45° FOV; retinal fundus photograph: 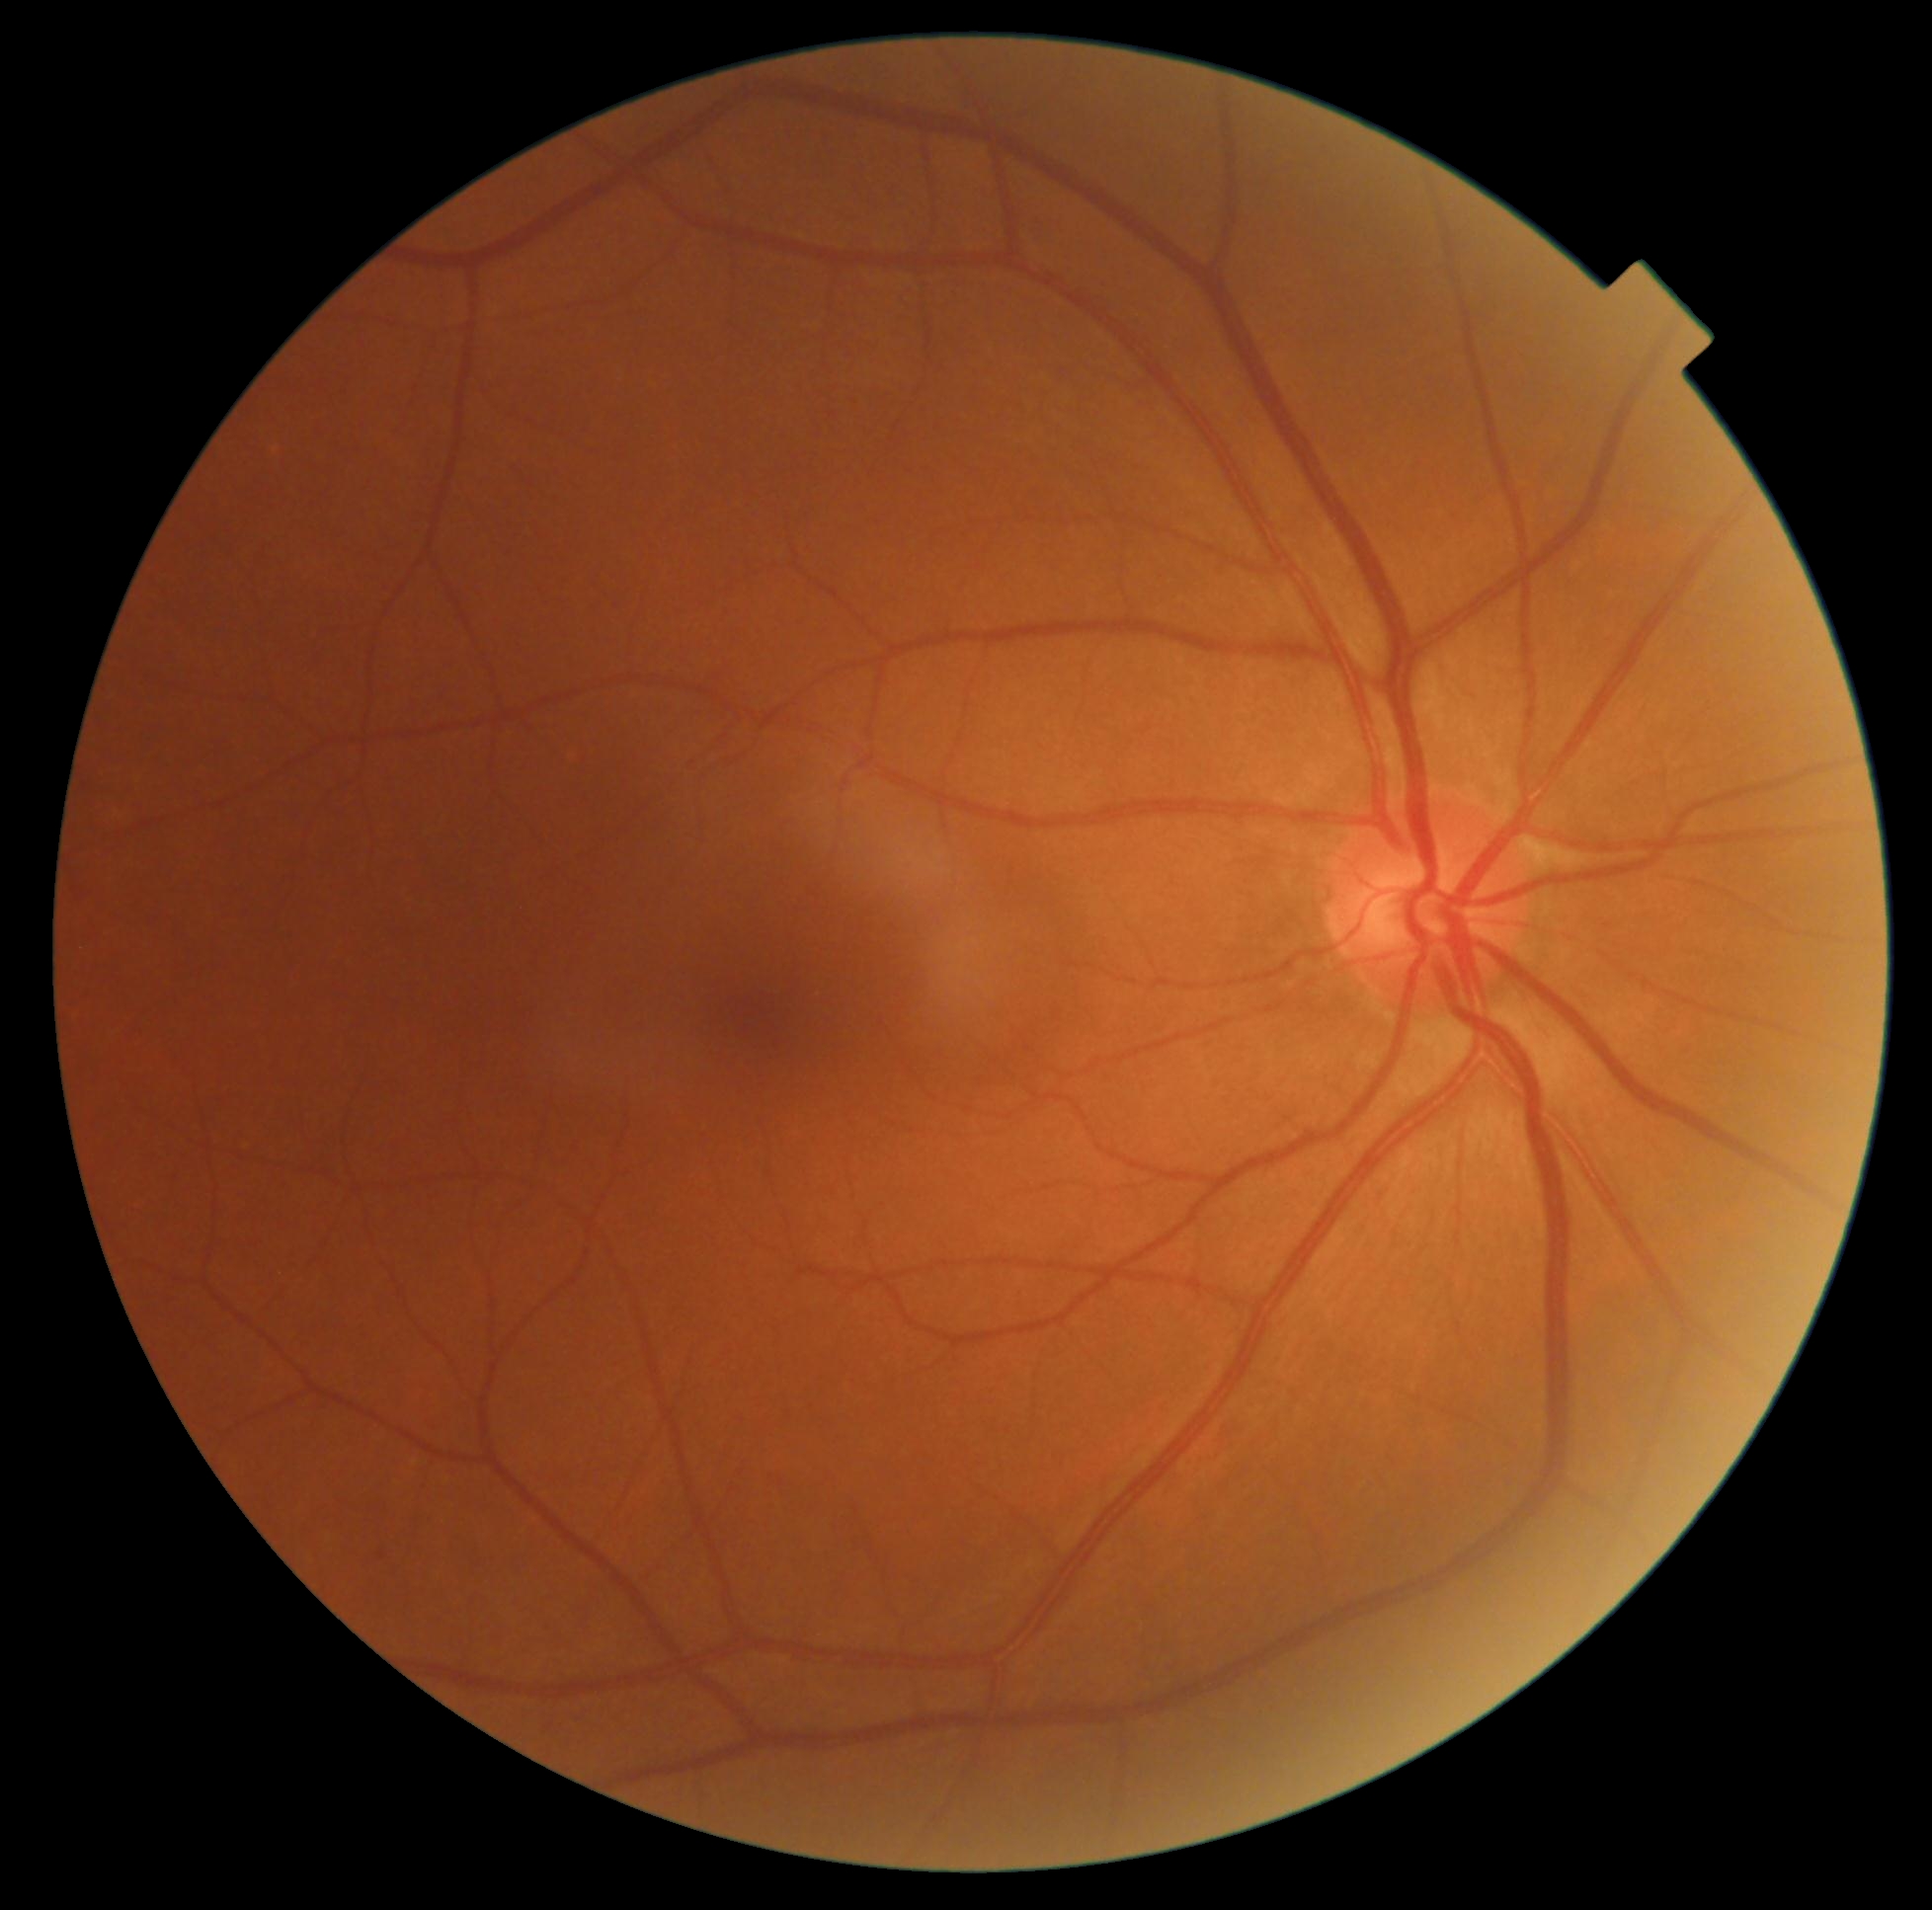 DR impression = no signs of DR, DR stage = grade 0 (no apparent retinopathy).